Diabetic retinopathy graded by the modified Davis classification.
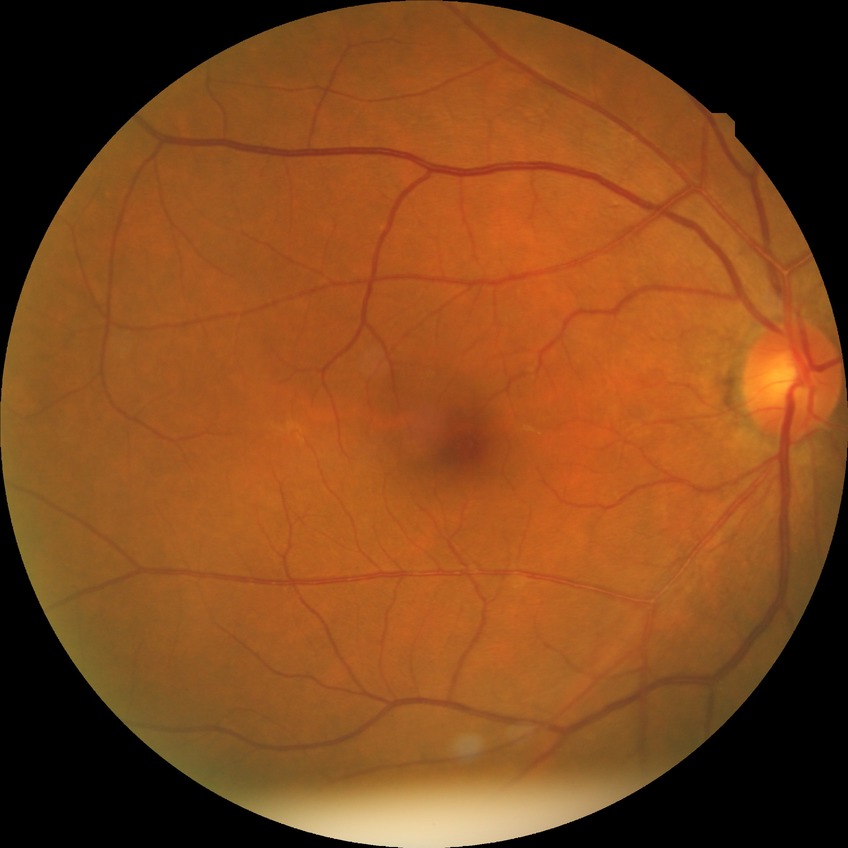
Davis grading is no diabetic retinopathy.